Modified Davis grading
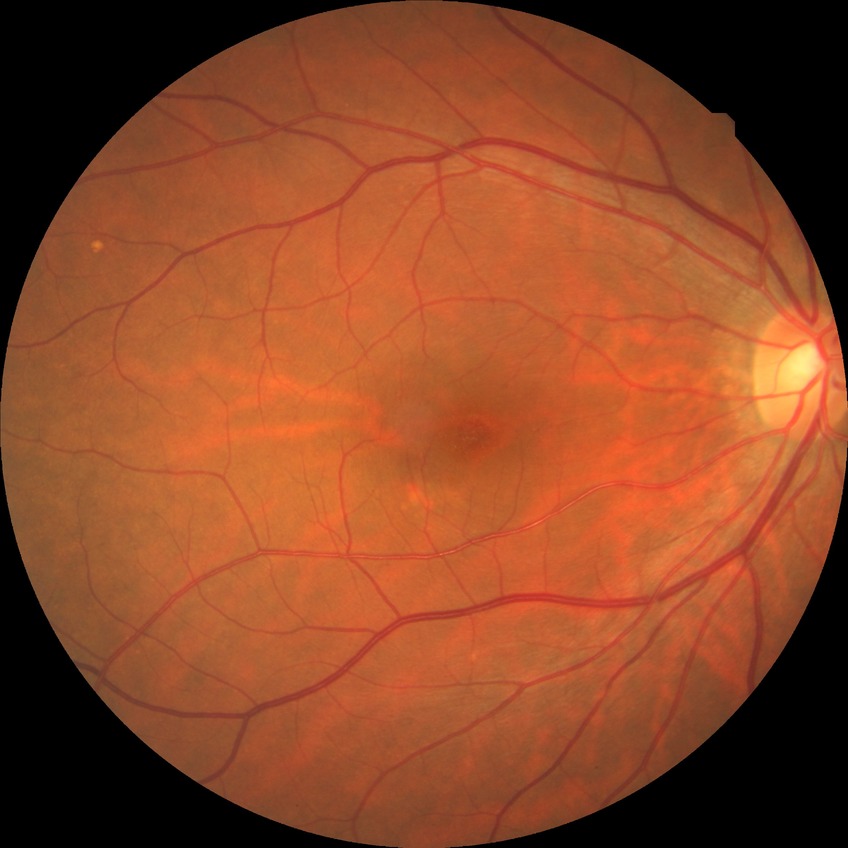 DR: NDR.